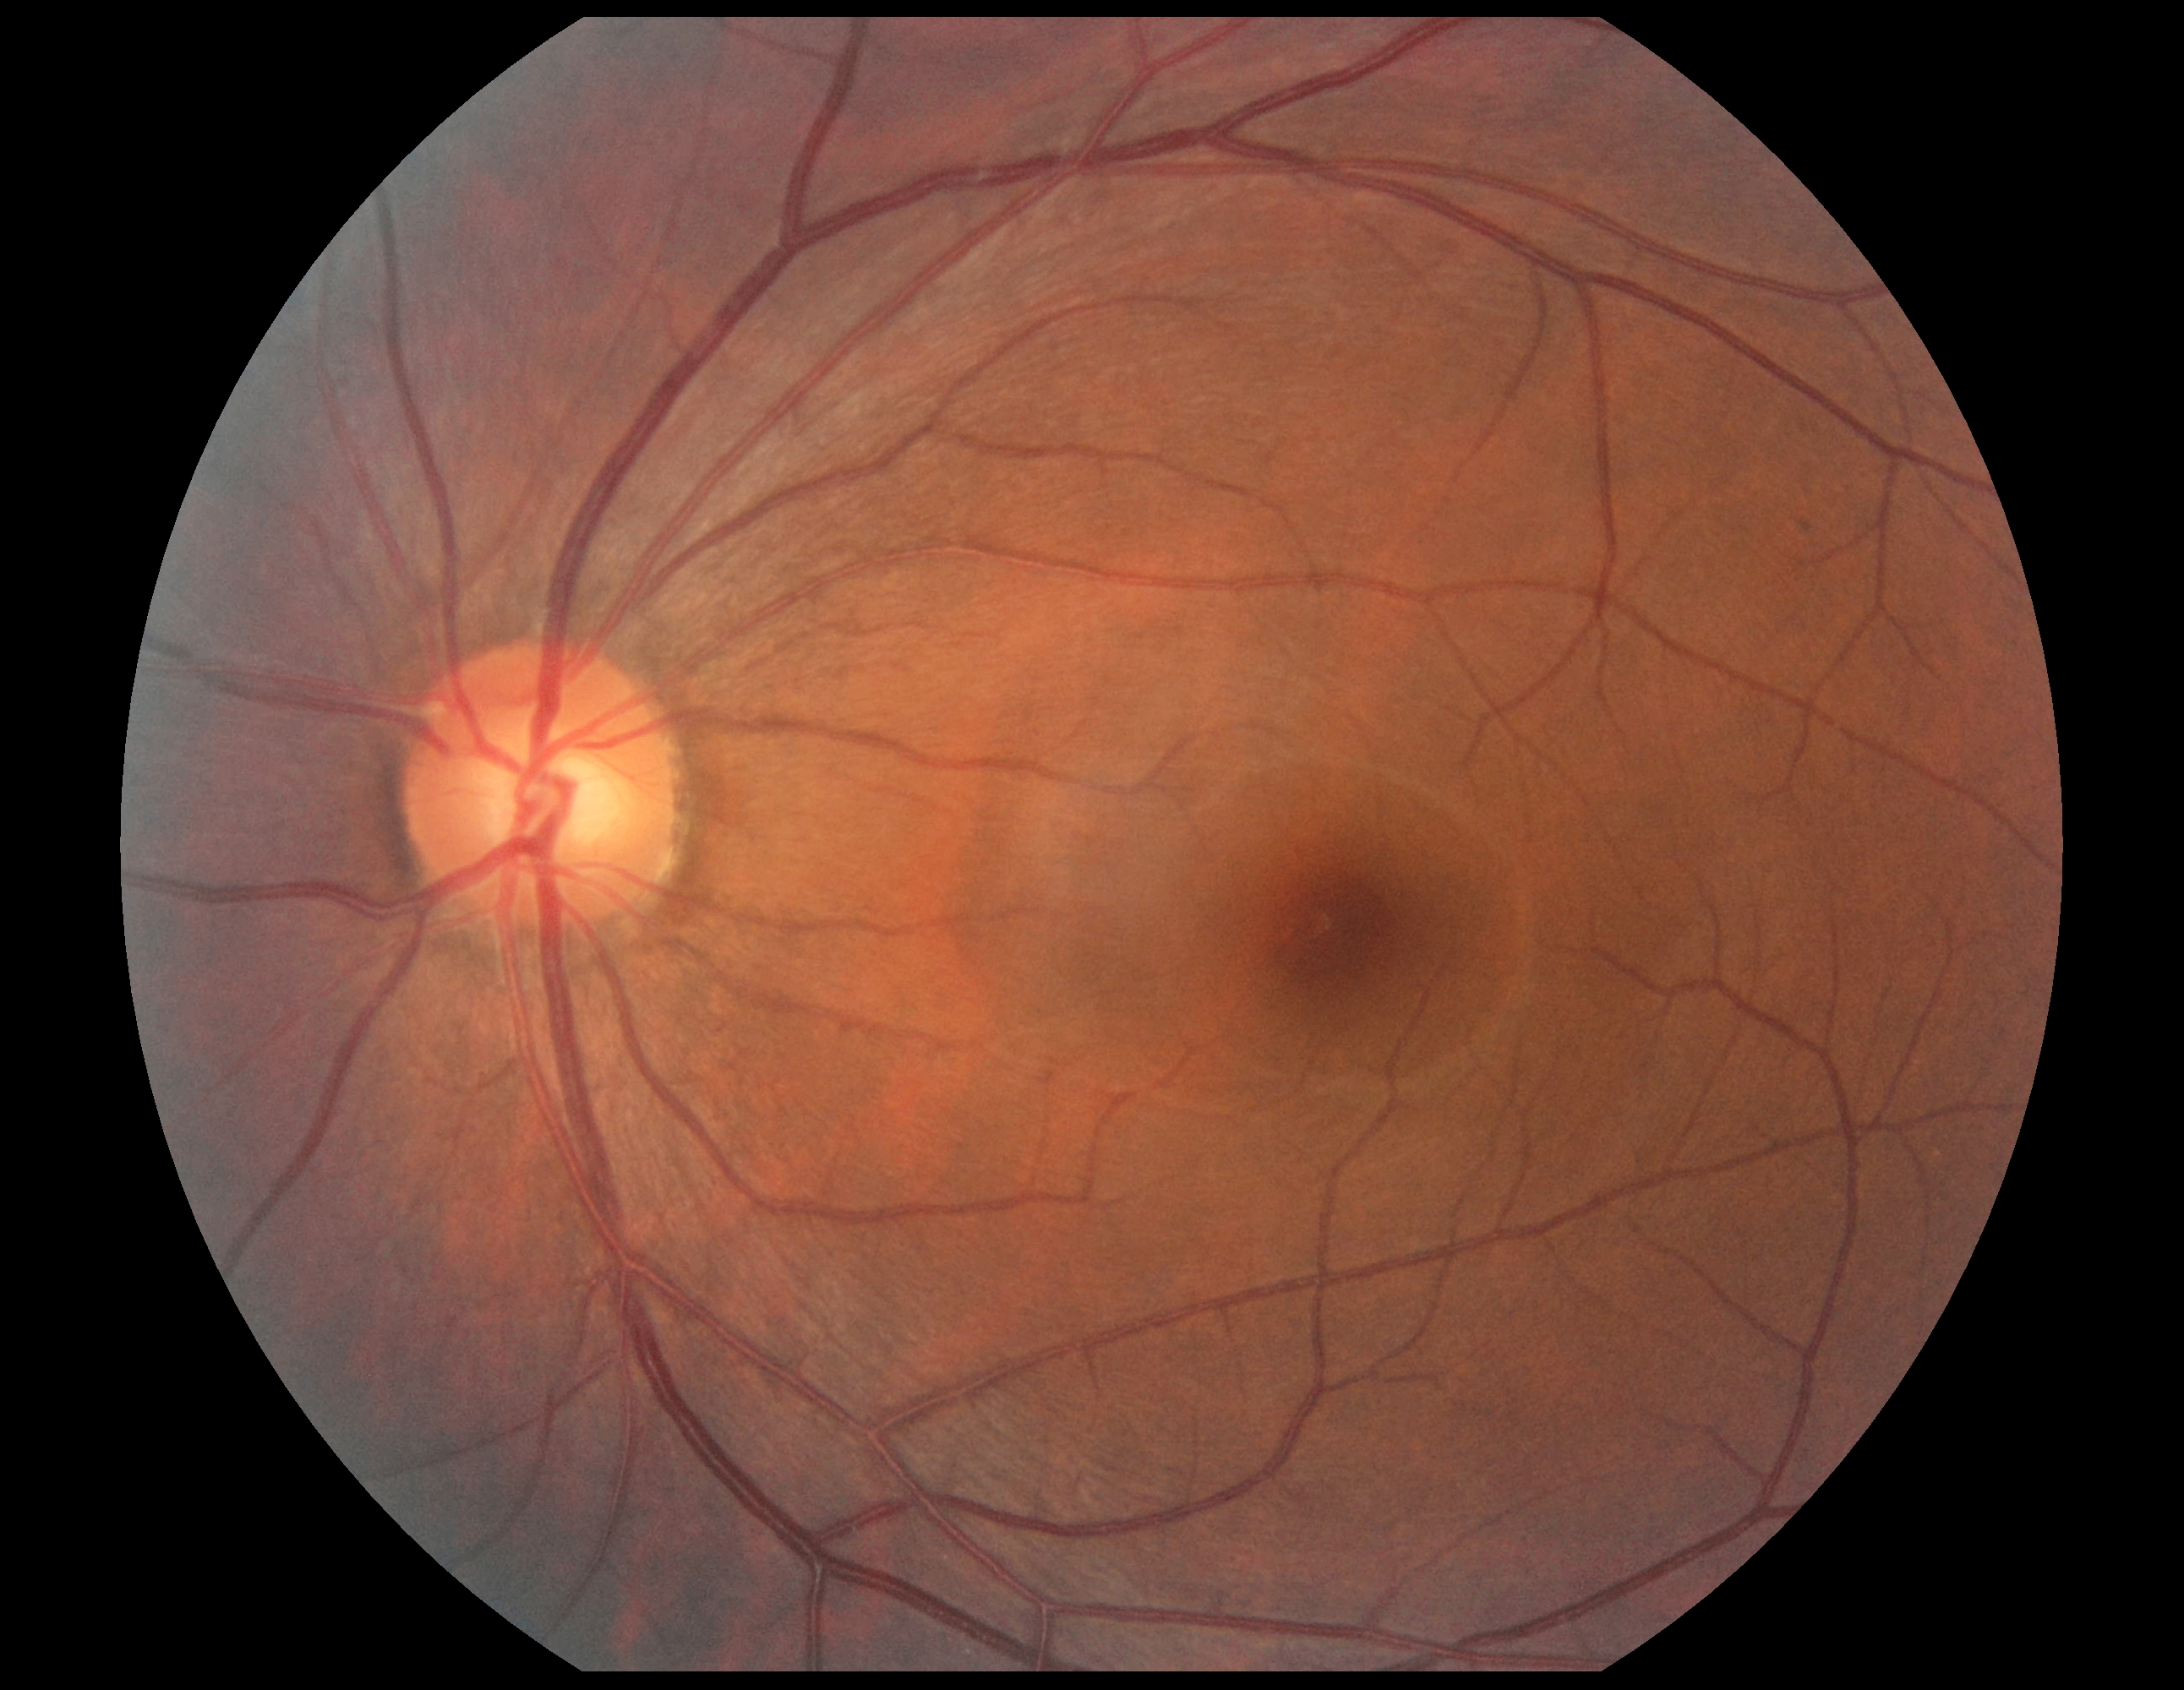
Diabetic retinopathy is grade 0 (no apparent retinopathy).
No signs of diabetic retinopathy.